CFP; nonmydriatic: 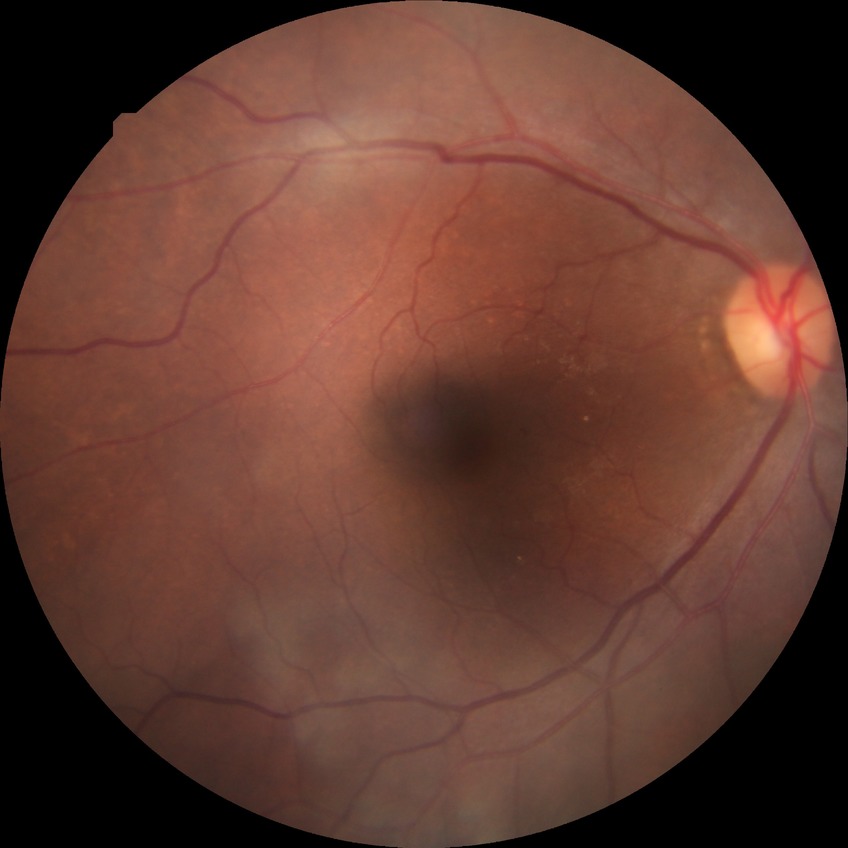 Diabetic retinopathy (DR) is NDR (no diabetic retinopathy).